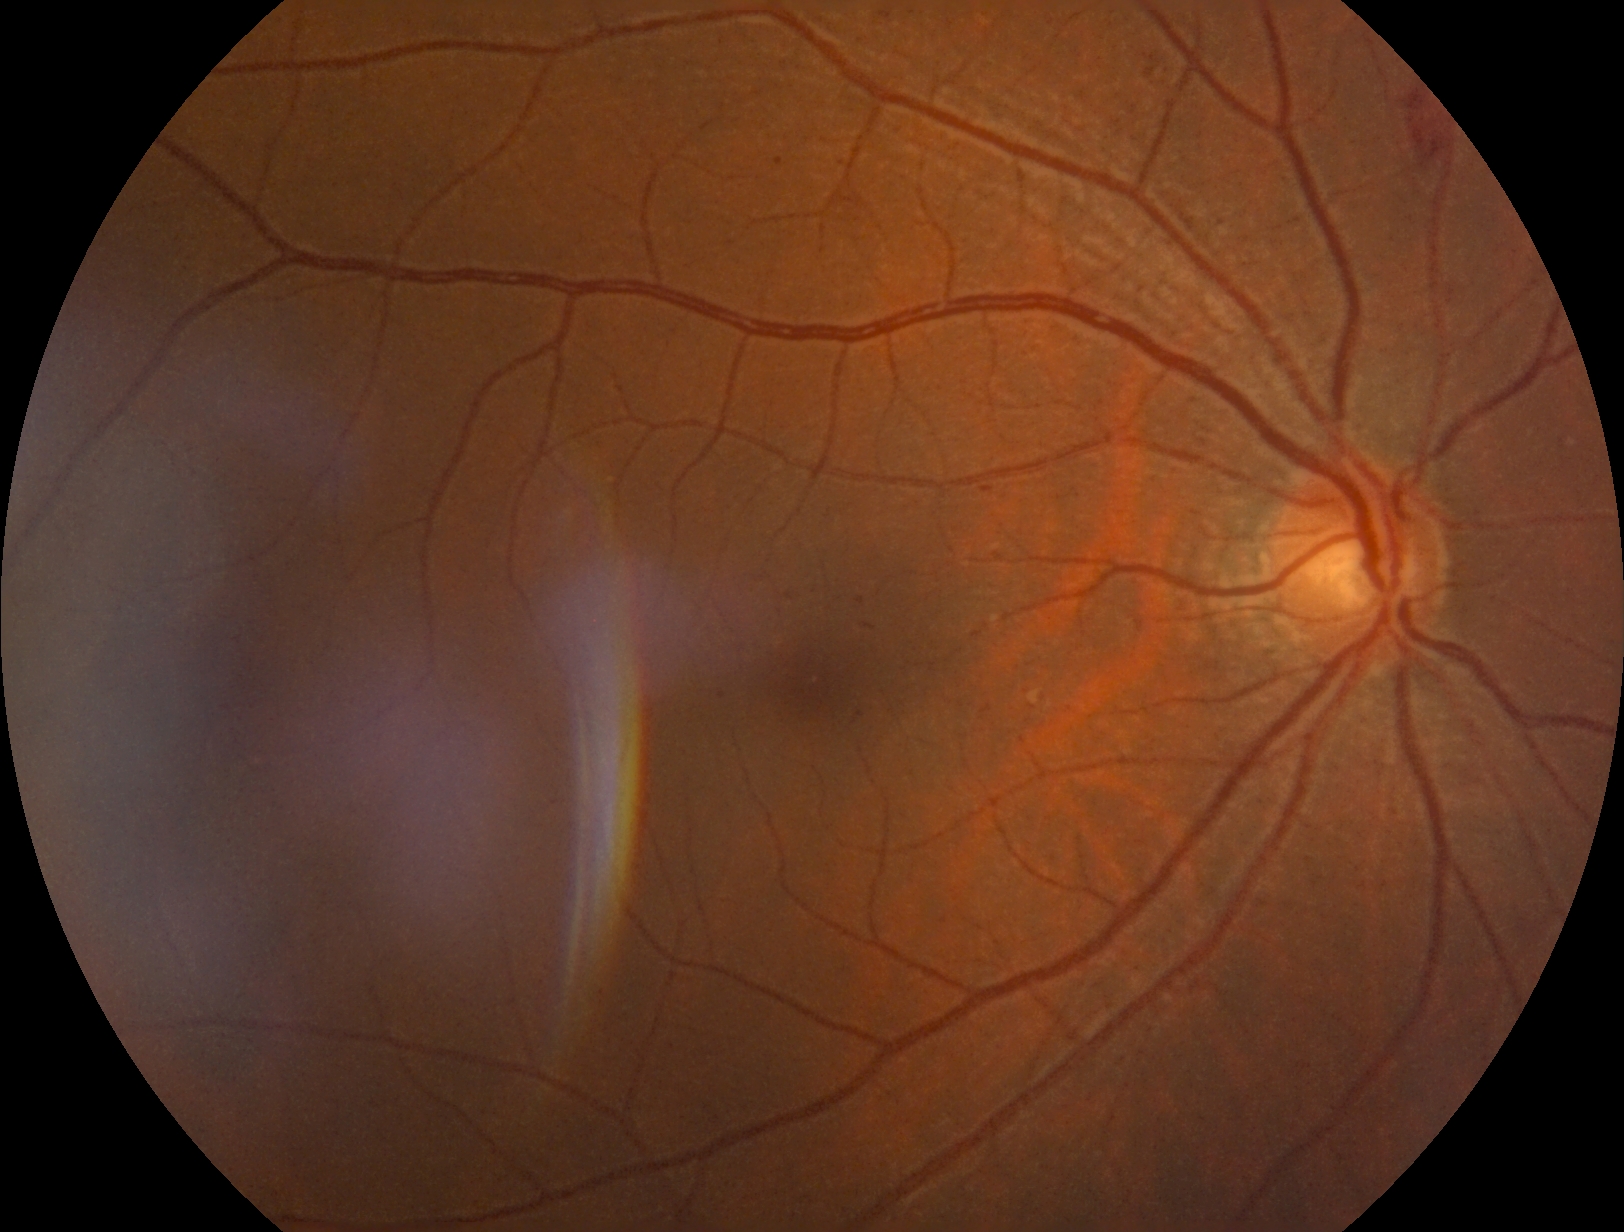

DR class: non-proliferative diabetic retinopathy.
DR: grade 2 (moderate NPDR).